2352 x 1568 pixels
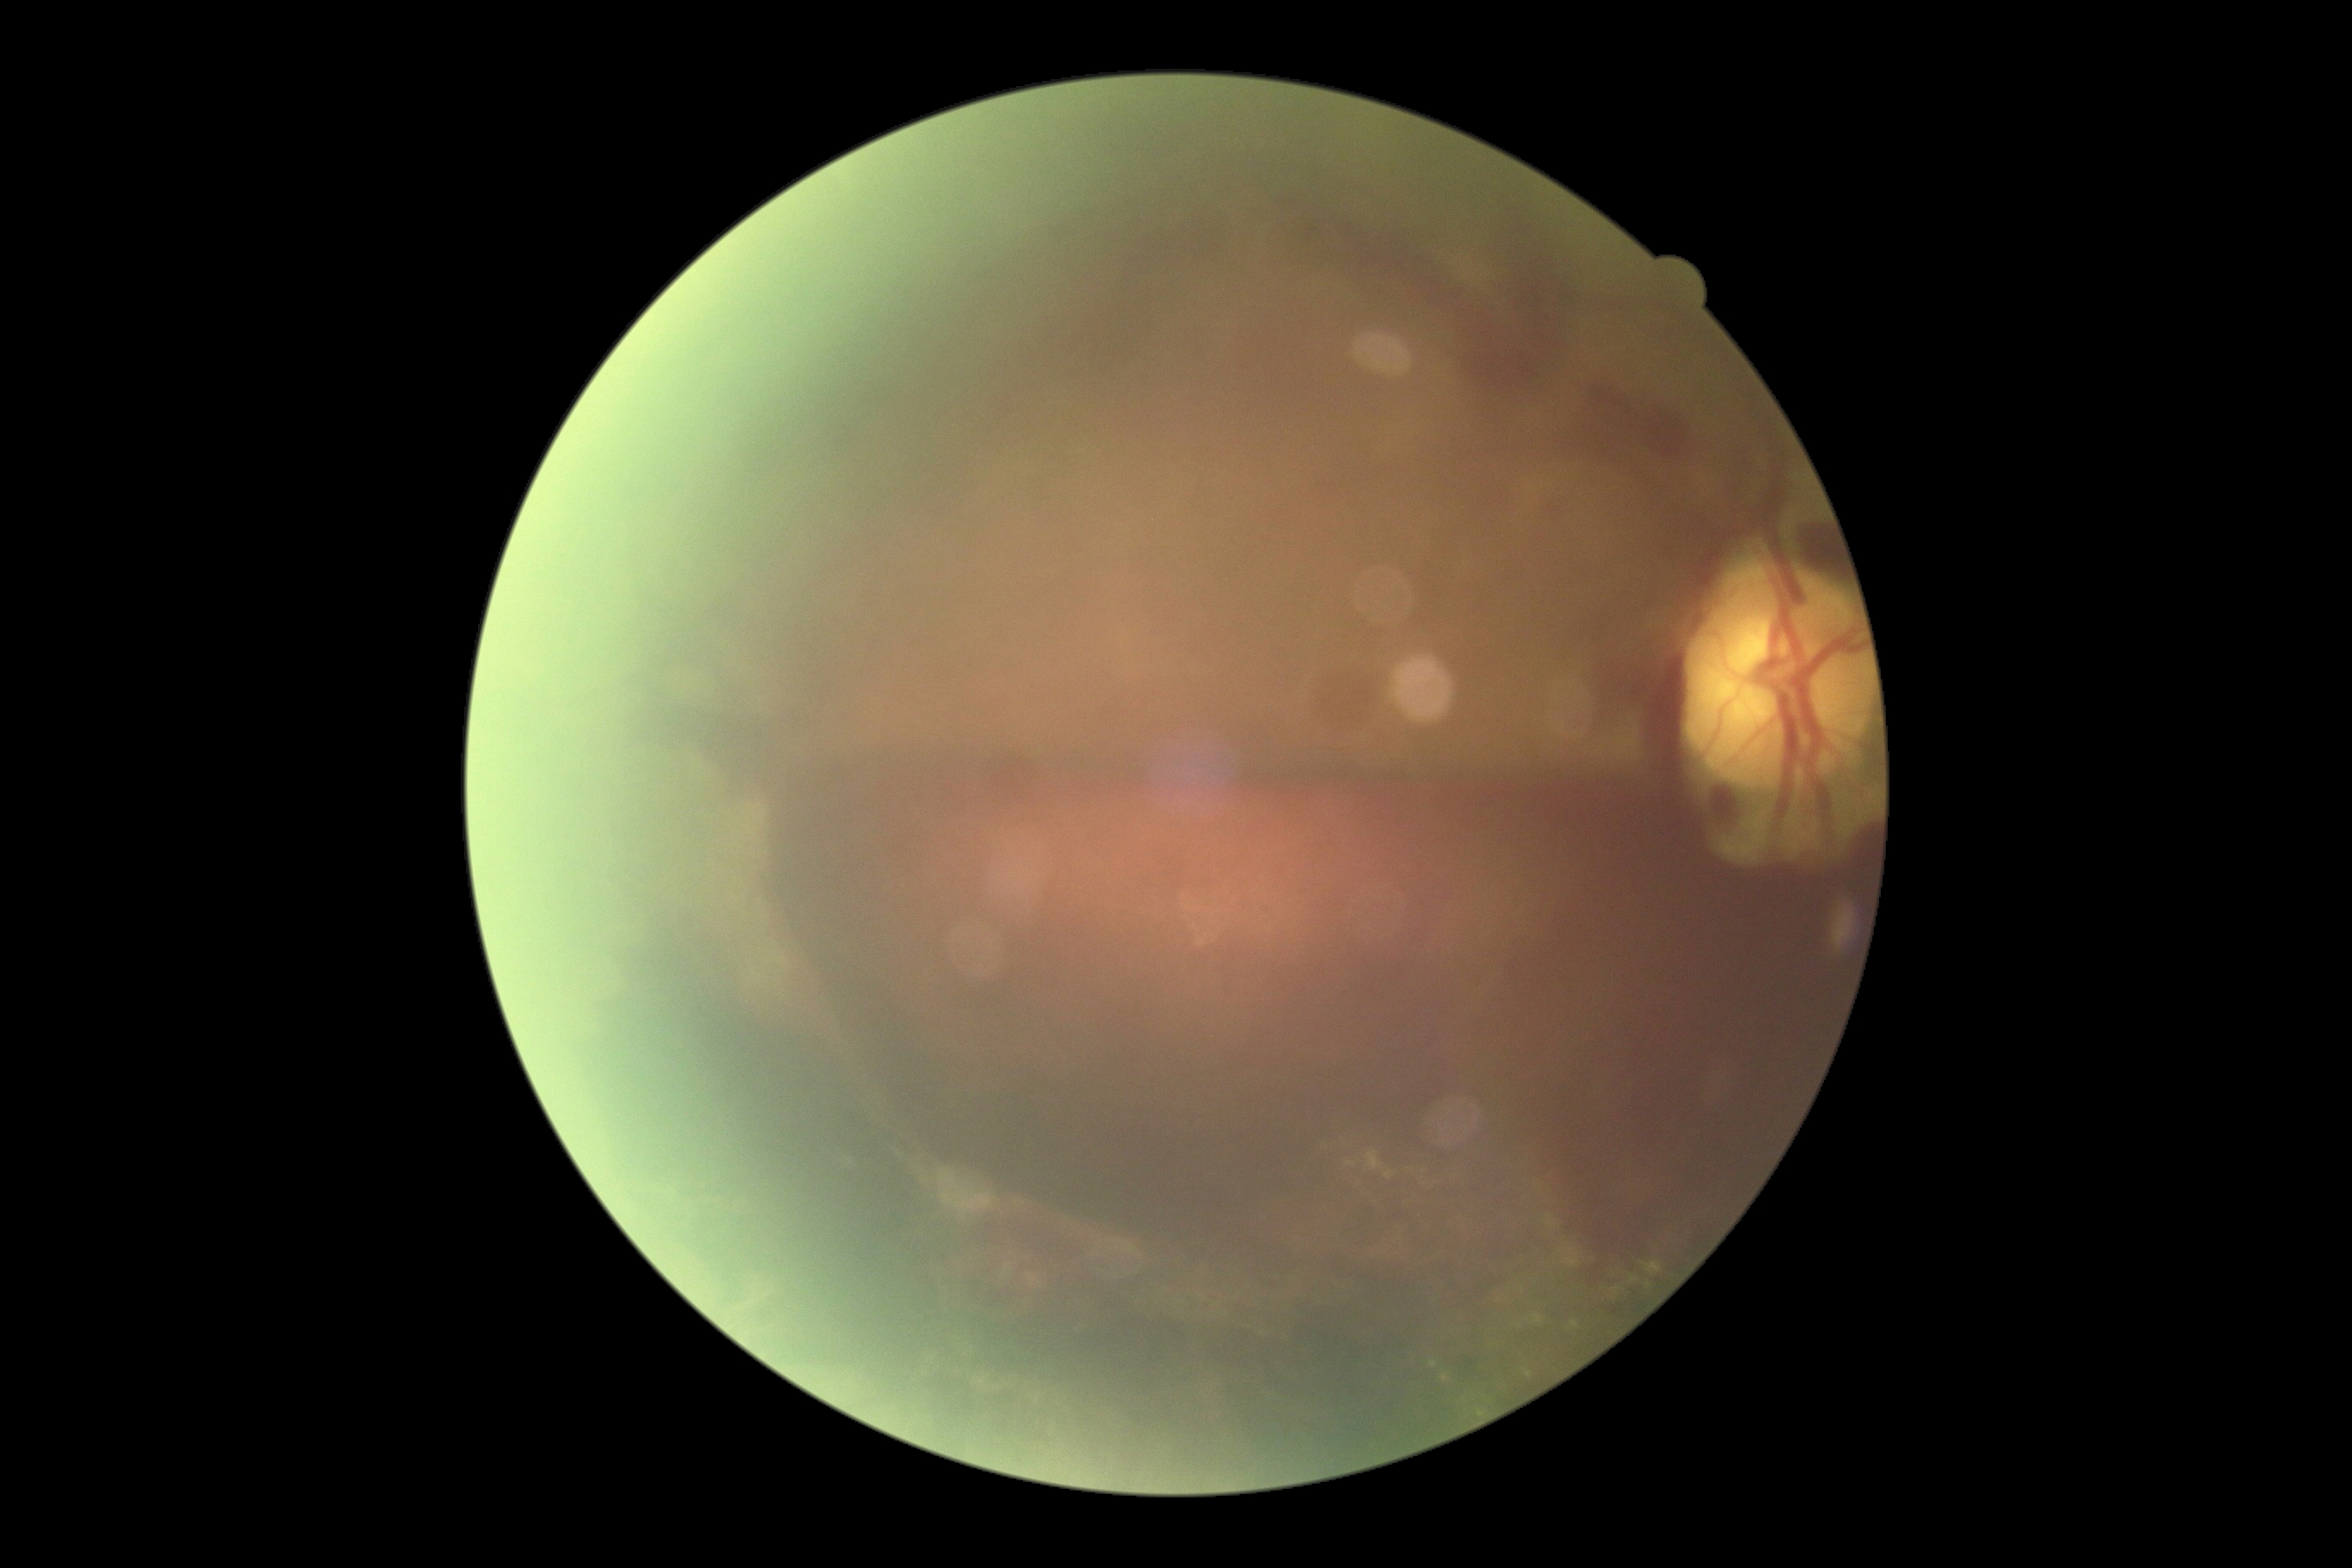 Diabetic retinopathy grade is proliferative diabetic retinopathy (4).